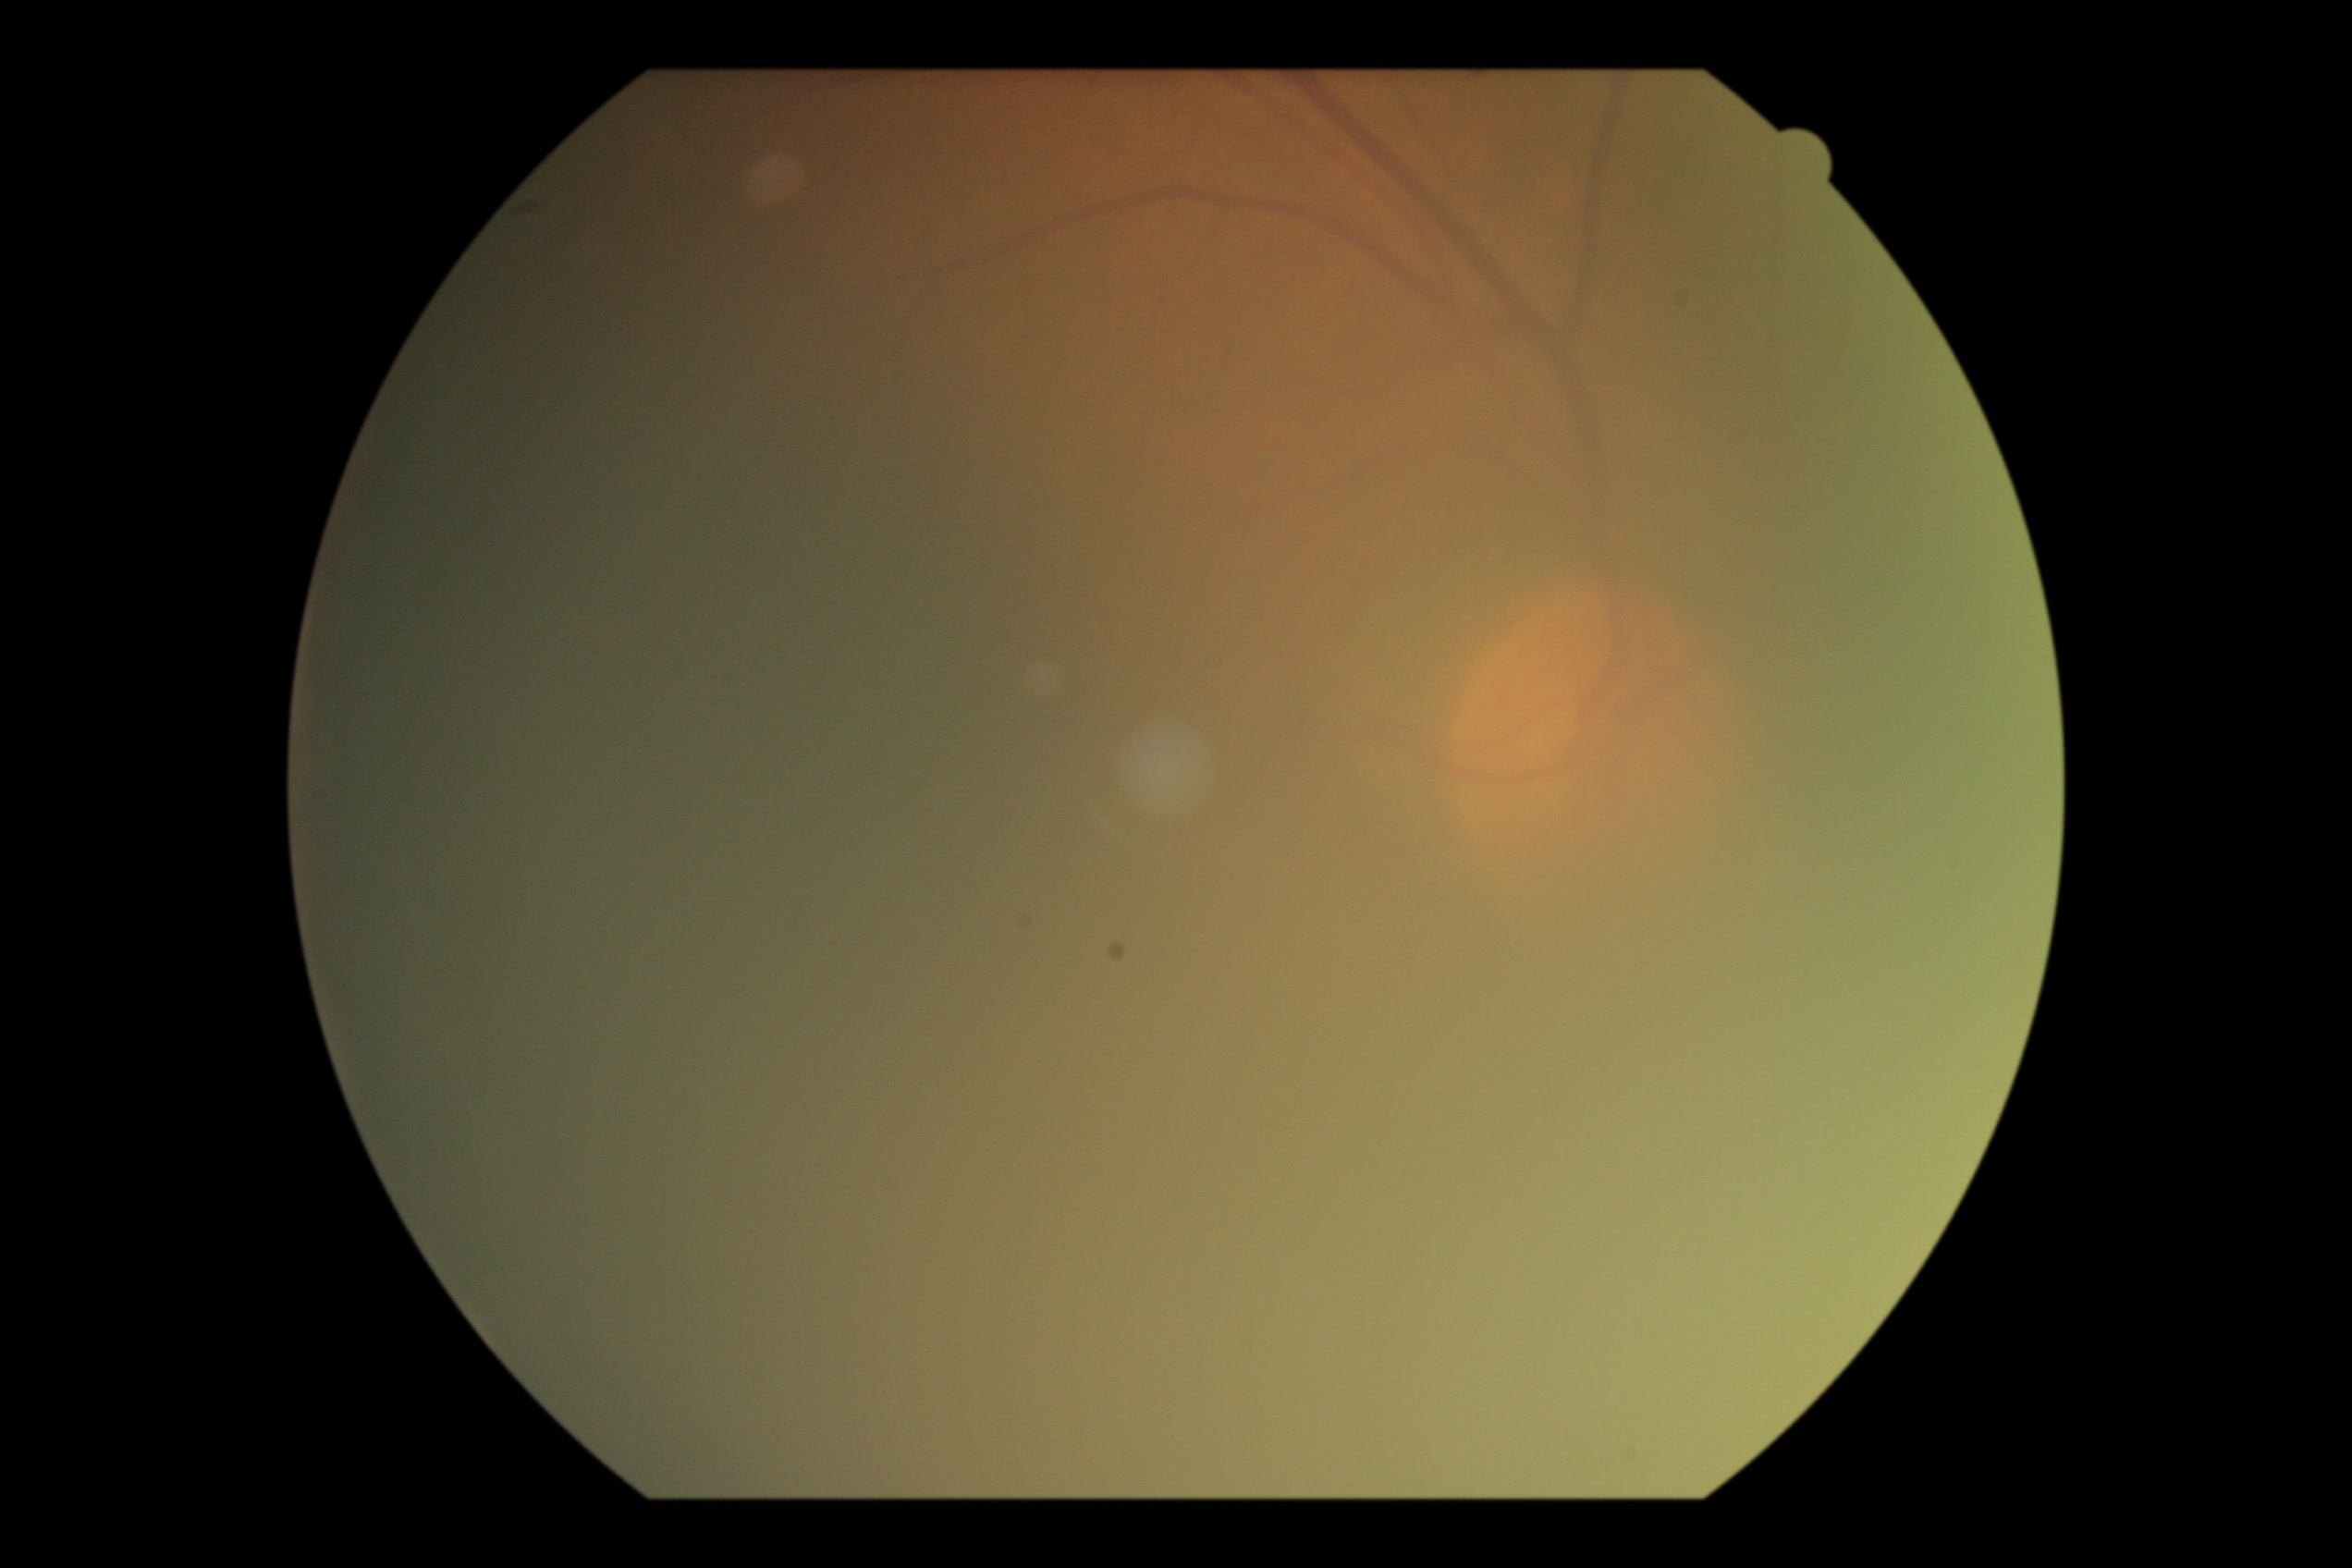
Ungradable image — DR severity cannot be determined. DR stage: ungradable.